Color fundus photograph:
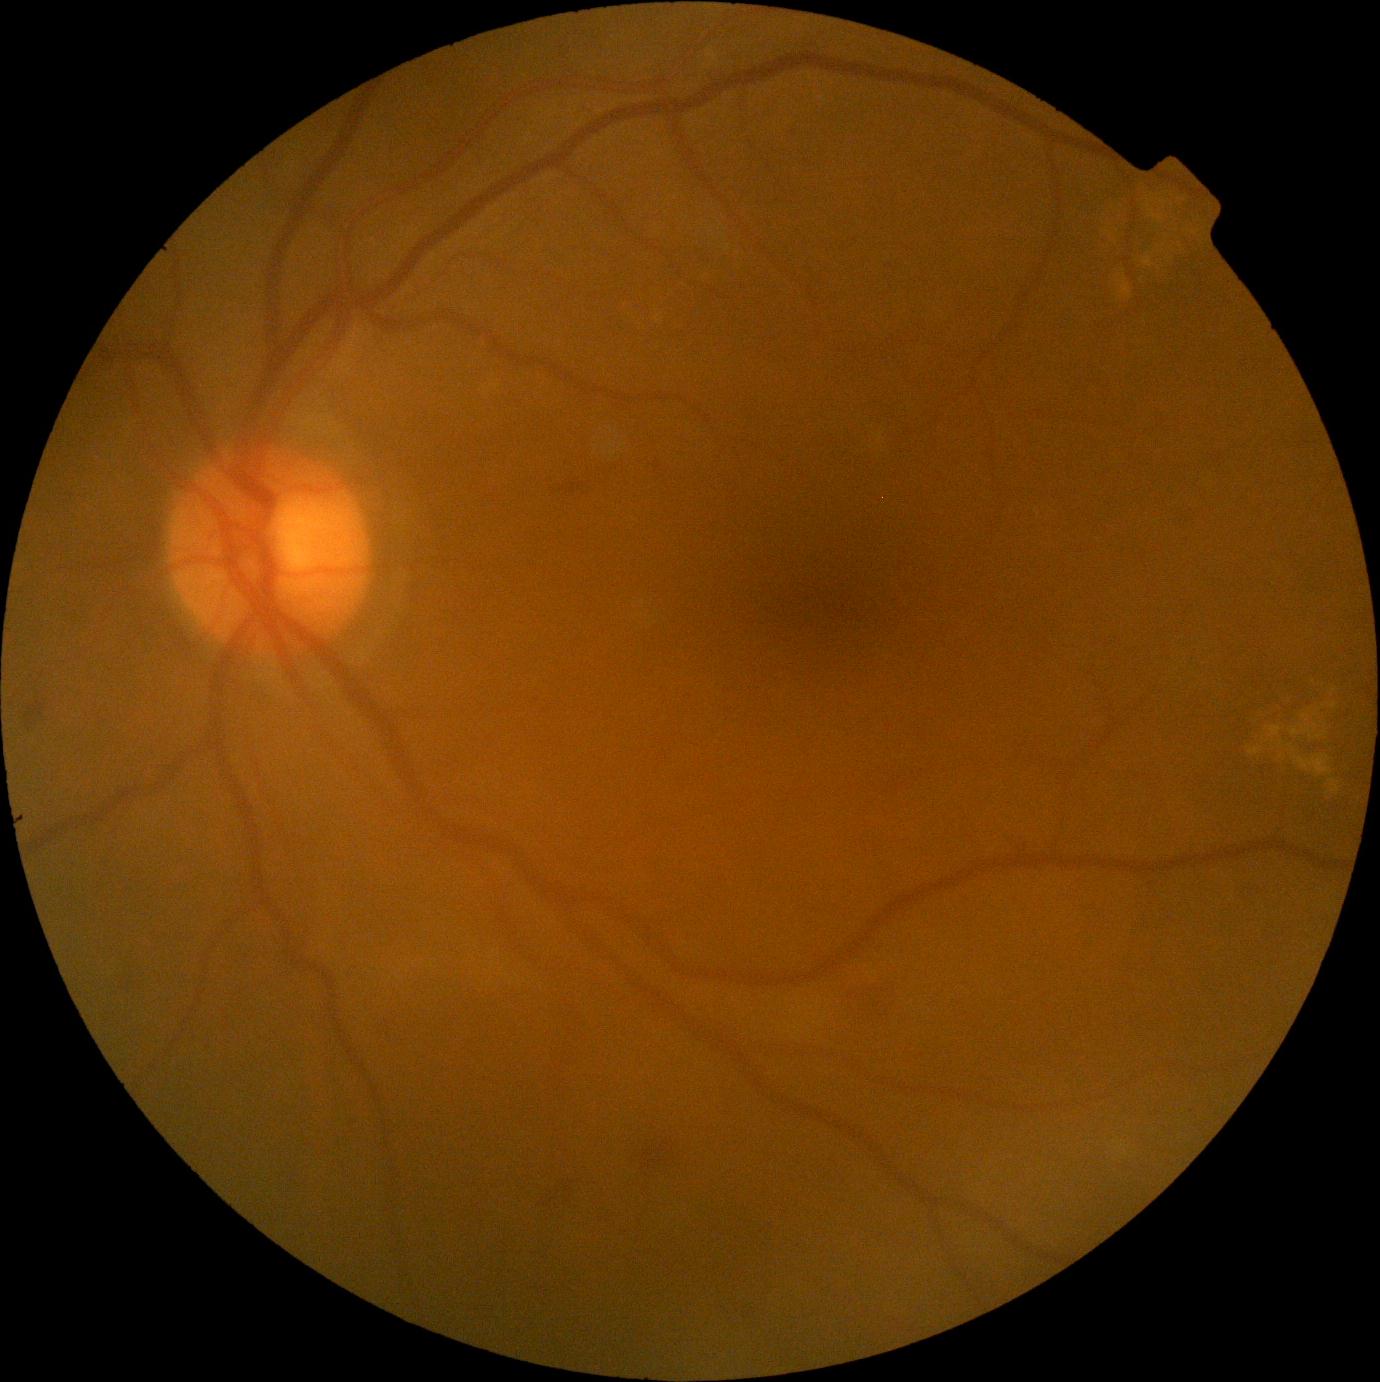

  dr_grade: moderate non-proliferative diabetic retinopathy (grade 2)